Image size 1440x1080. Infant wide-field fundus photograph. Camera: Natus RetCam Envision (130° FOV) — 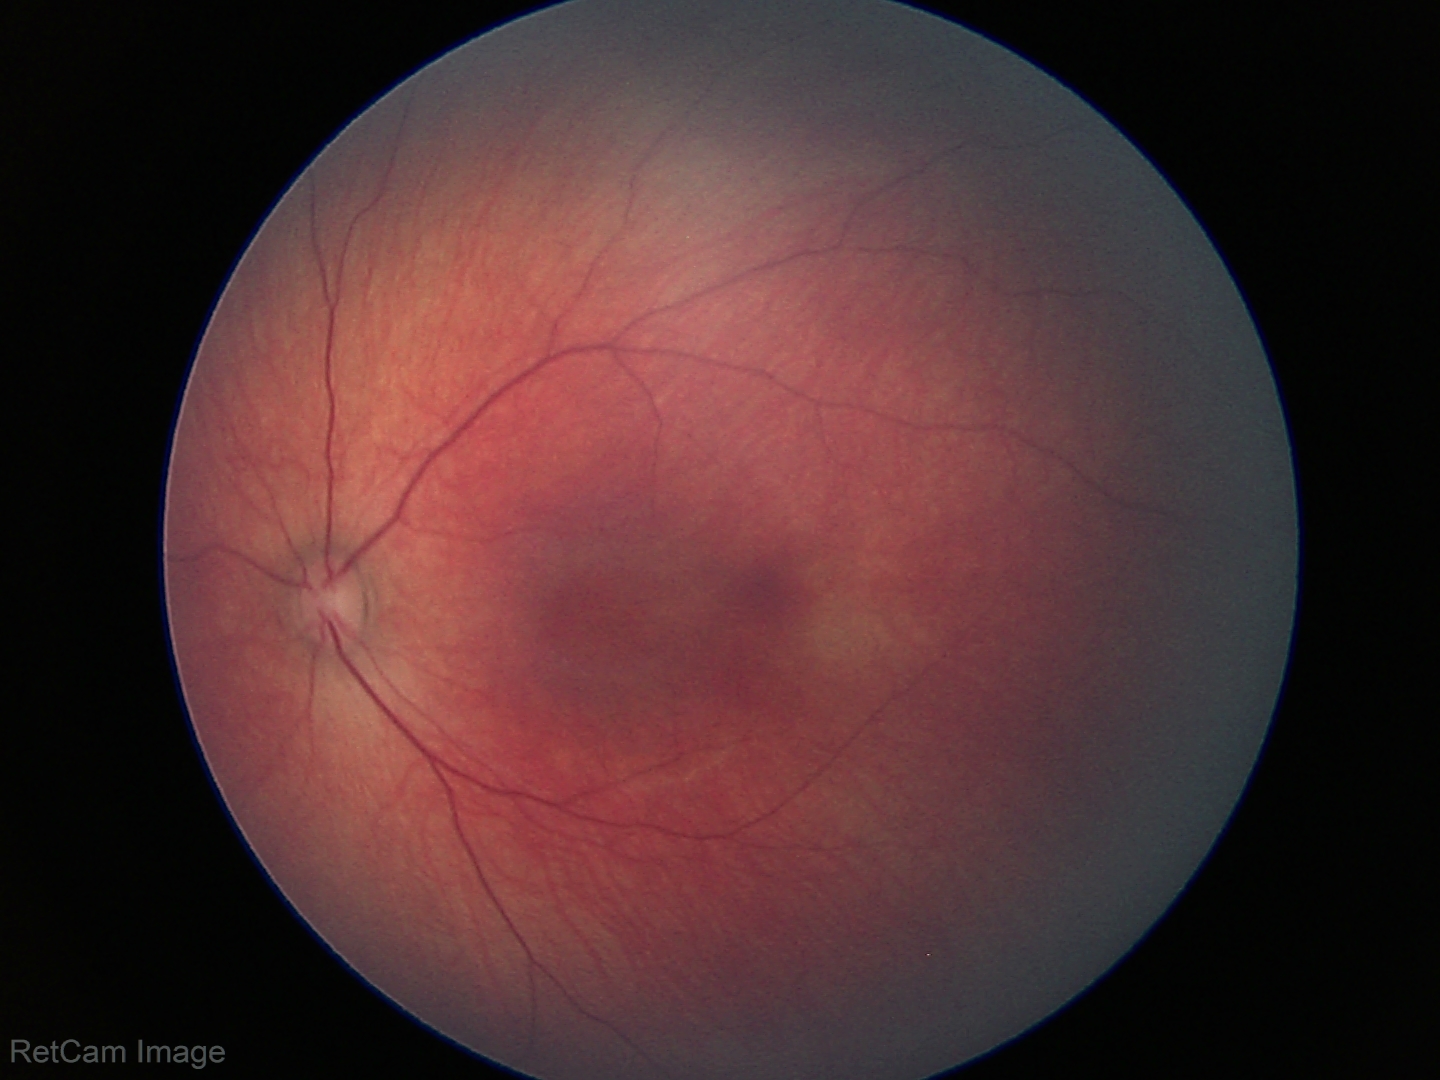 Screening diagnosis: no abnormal retinal findings.